Retinal fundus photograph:
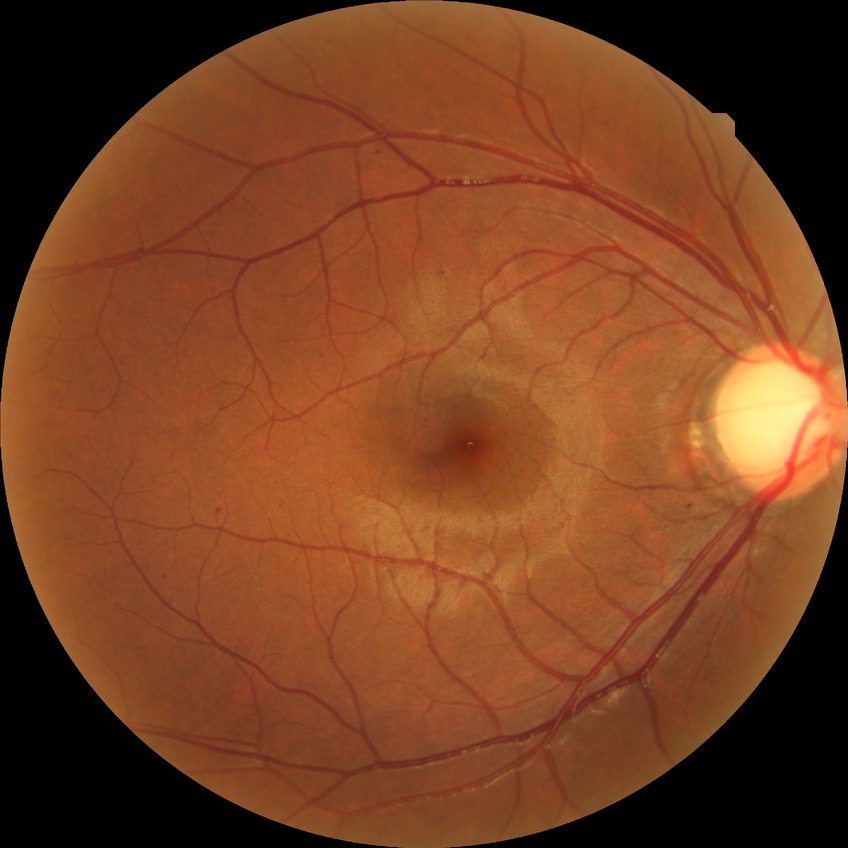
DR severity: SDR.